Posterior pole photograph:
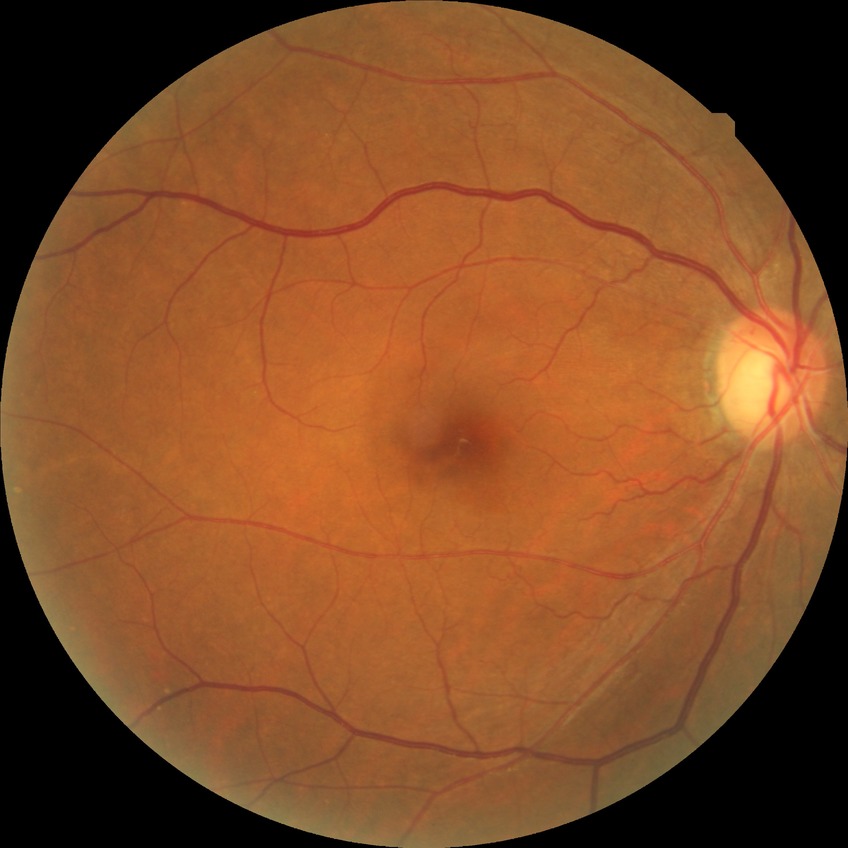
retinopathy stage: no diabetic retinopathy.